RetCam wide-field infant fundus image. 640 by 480 pixels. Captured with the Clarity RetCam 3 (130° field of view) — 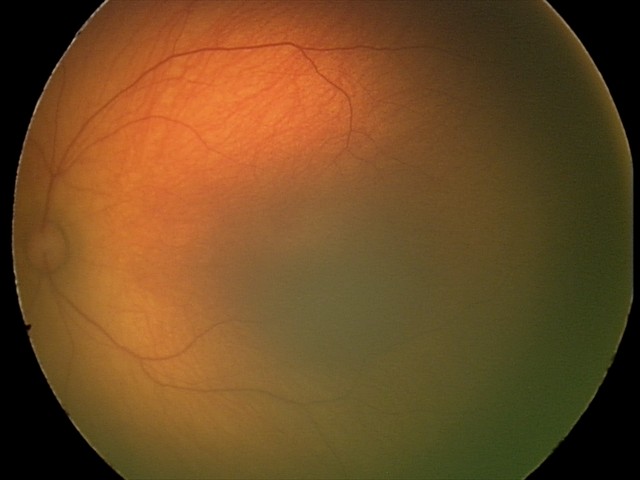
Finding: physiological.